Pediatric retinal photograph (wide-field)
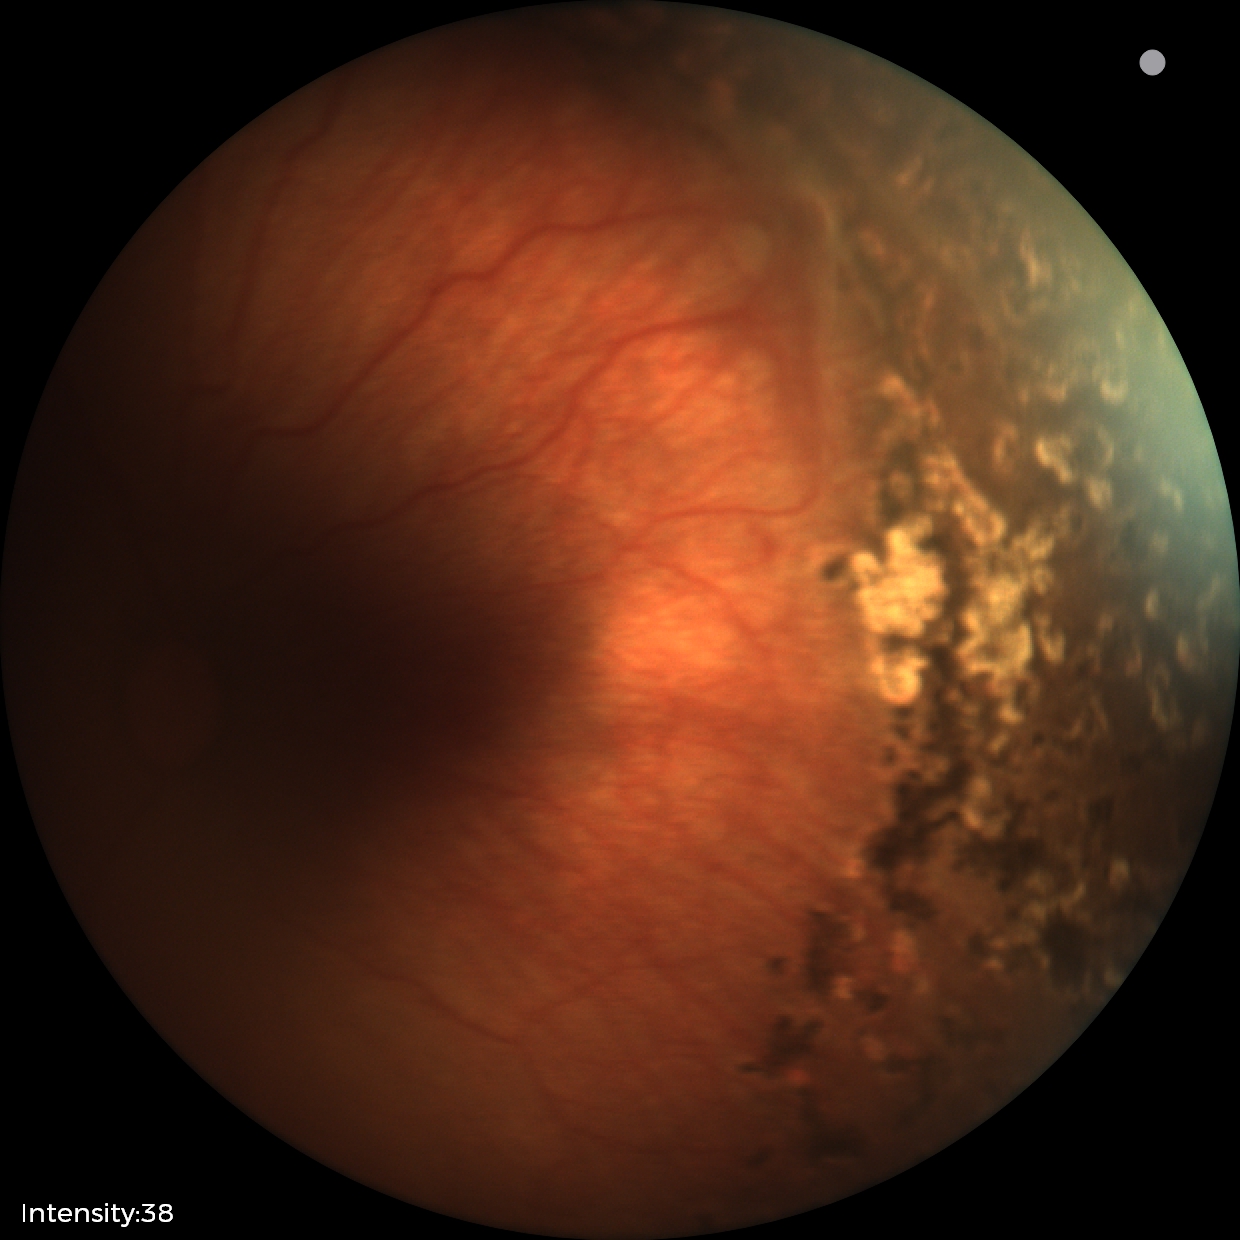 Examination diagnosed as status post retinopathy of prematurity. Plus disease absent.